45-degree field of view — 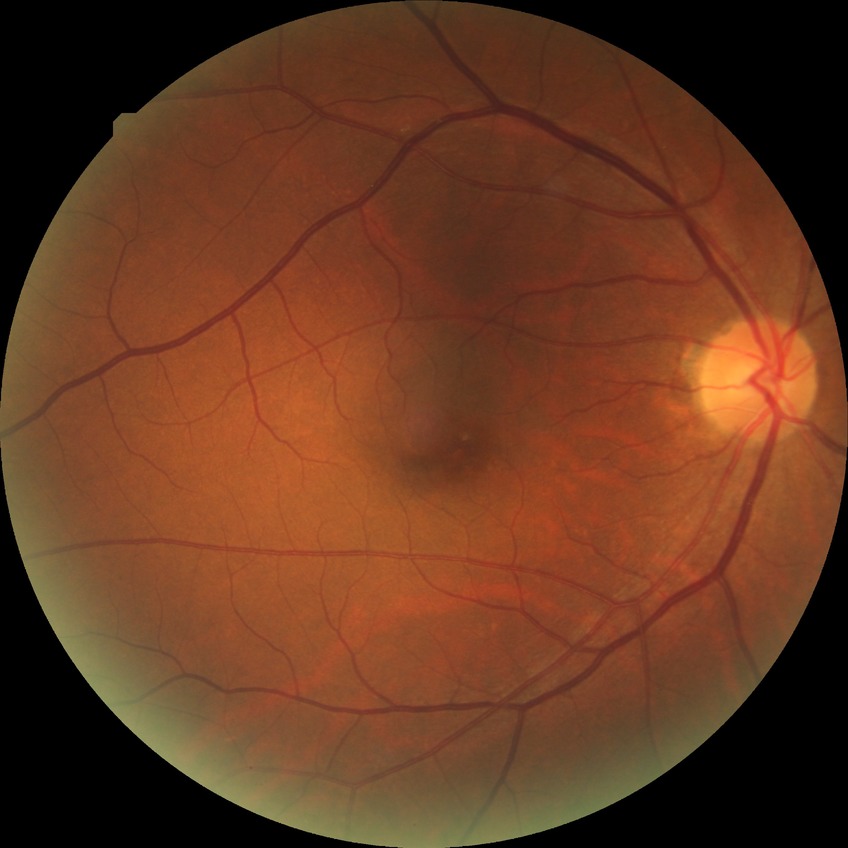

{"davis_grade": "no diabetic retinopathy (NDR)"}